Diabetic retinopathy graded by the modified Davis classification:
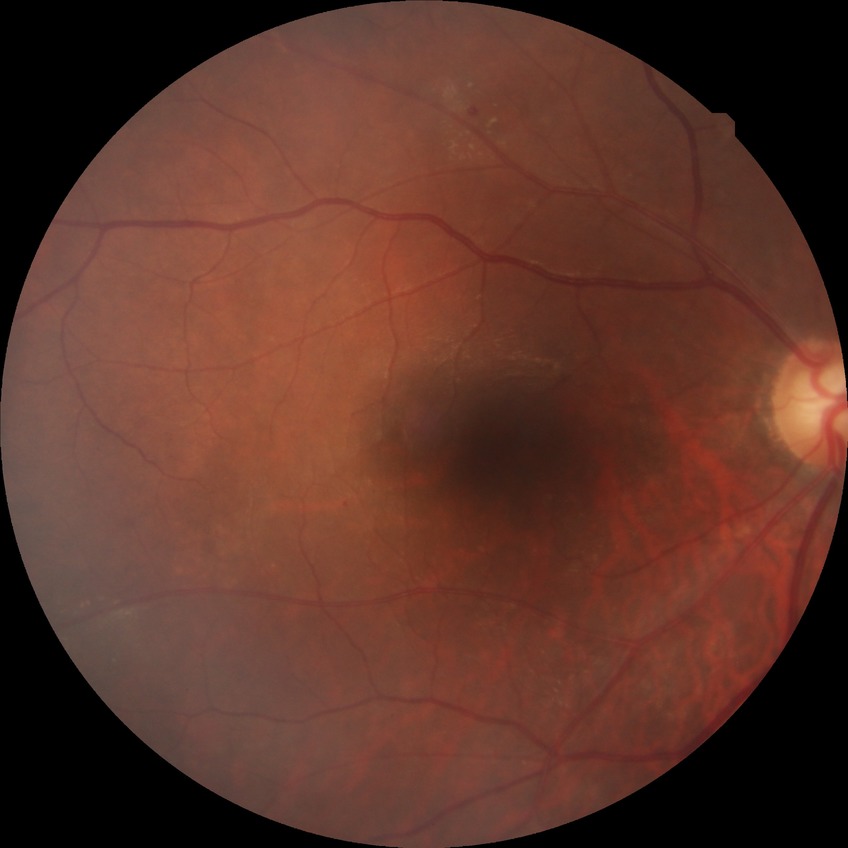

Diabetic retinopathy (DR) is simple diabetic retinopathy (SDR).